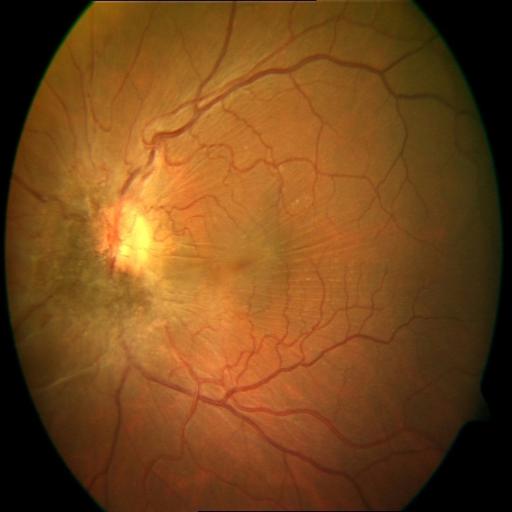

Findings consistent with RT (retinal traction).